Retinal fundus photograph · camera: NIDEK AFC-230
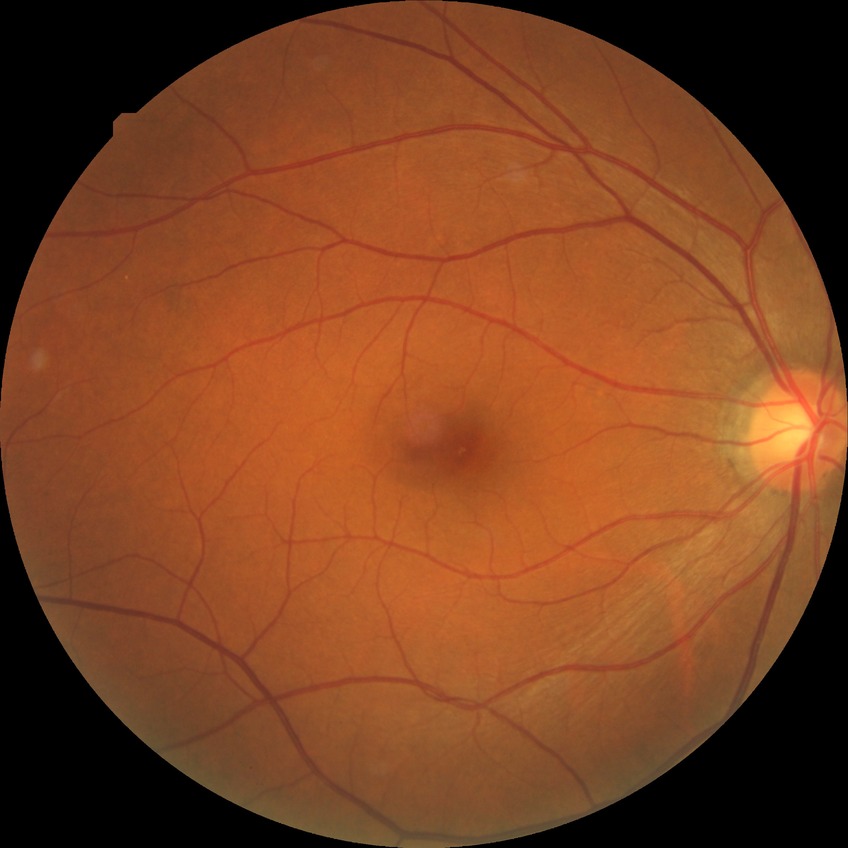 No apparent diabetic retinopathy. DR grade: NDR.